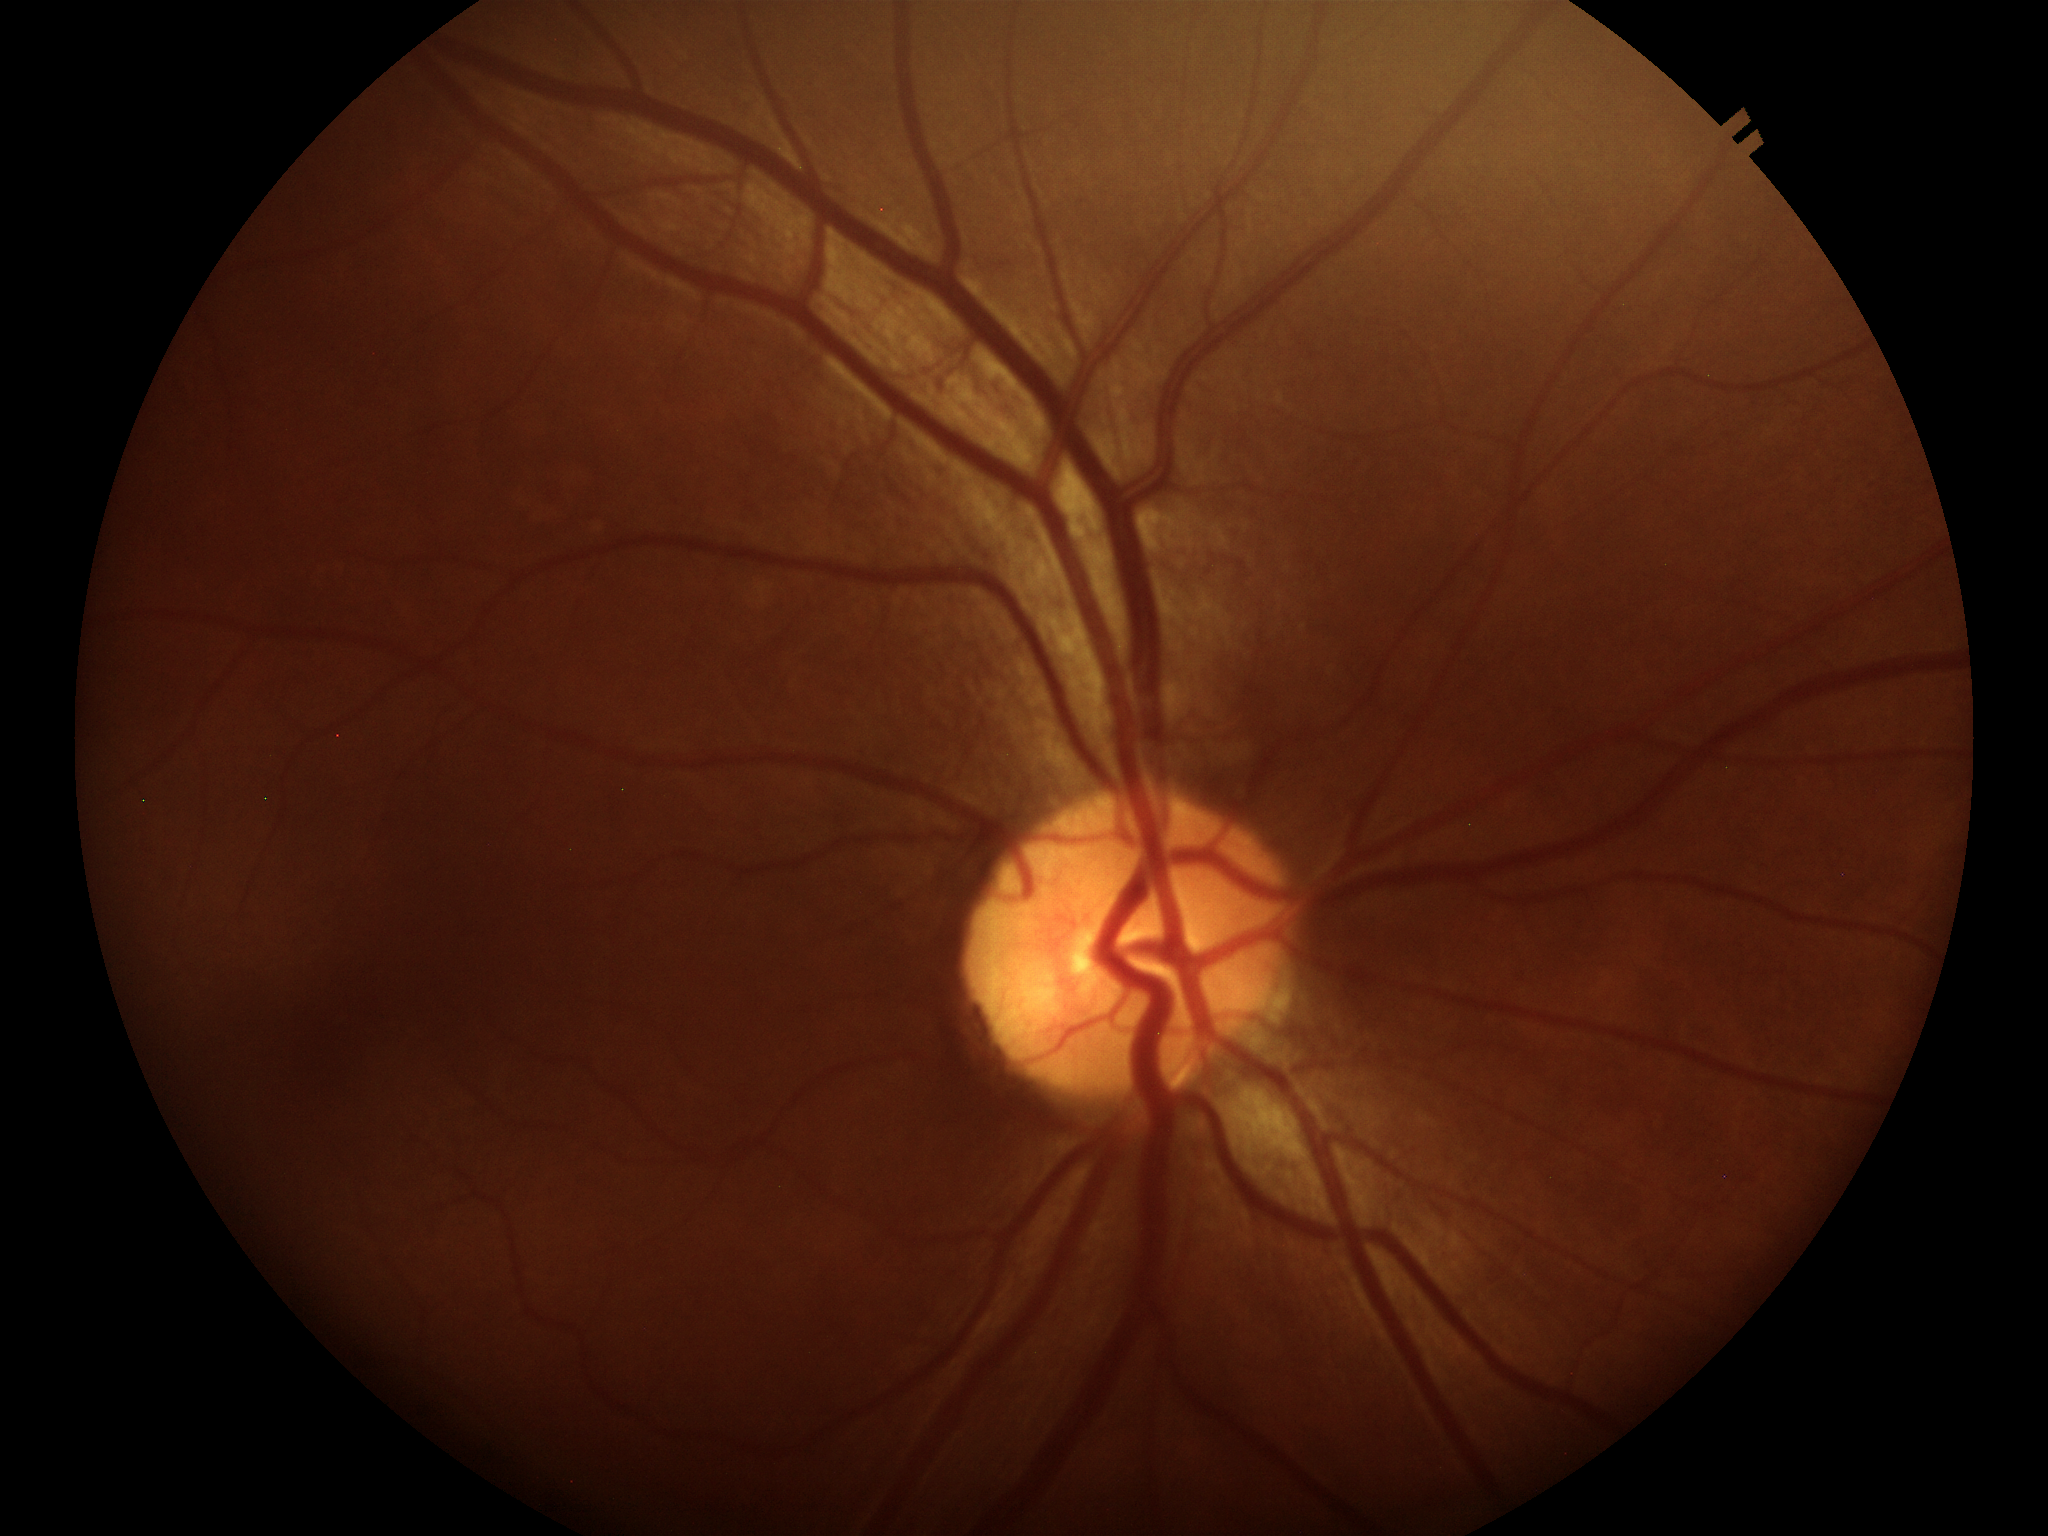

Glaucoma decision: negative.
Horizontal cup-to-disc ratio (HCDR): 0.45.
Area cup-disc ratio (ACDR): 0.16.
Vertical cup-to-disc ratio (VCDR) is 0.36.